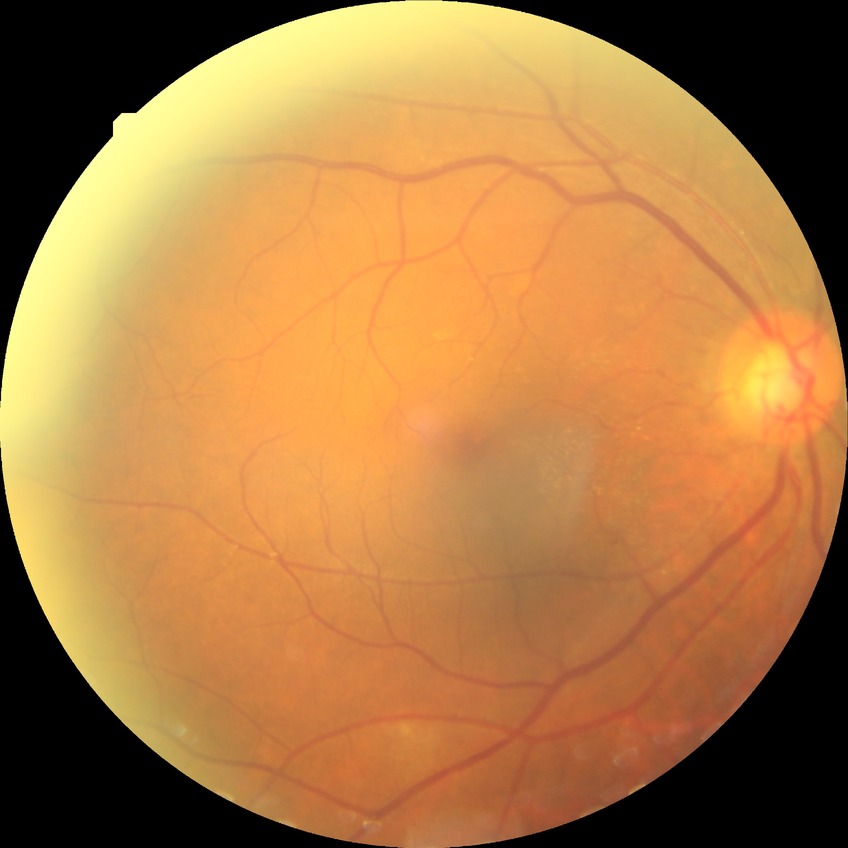

Retinopathy stage: no diabetic retinopathy.